Camera: Topcon TRC-NW8:
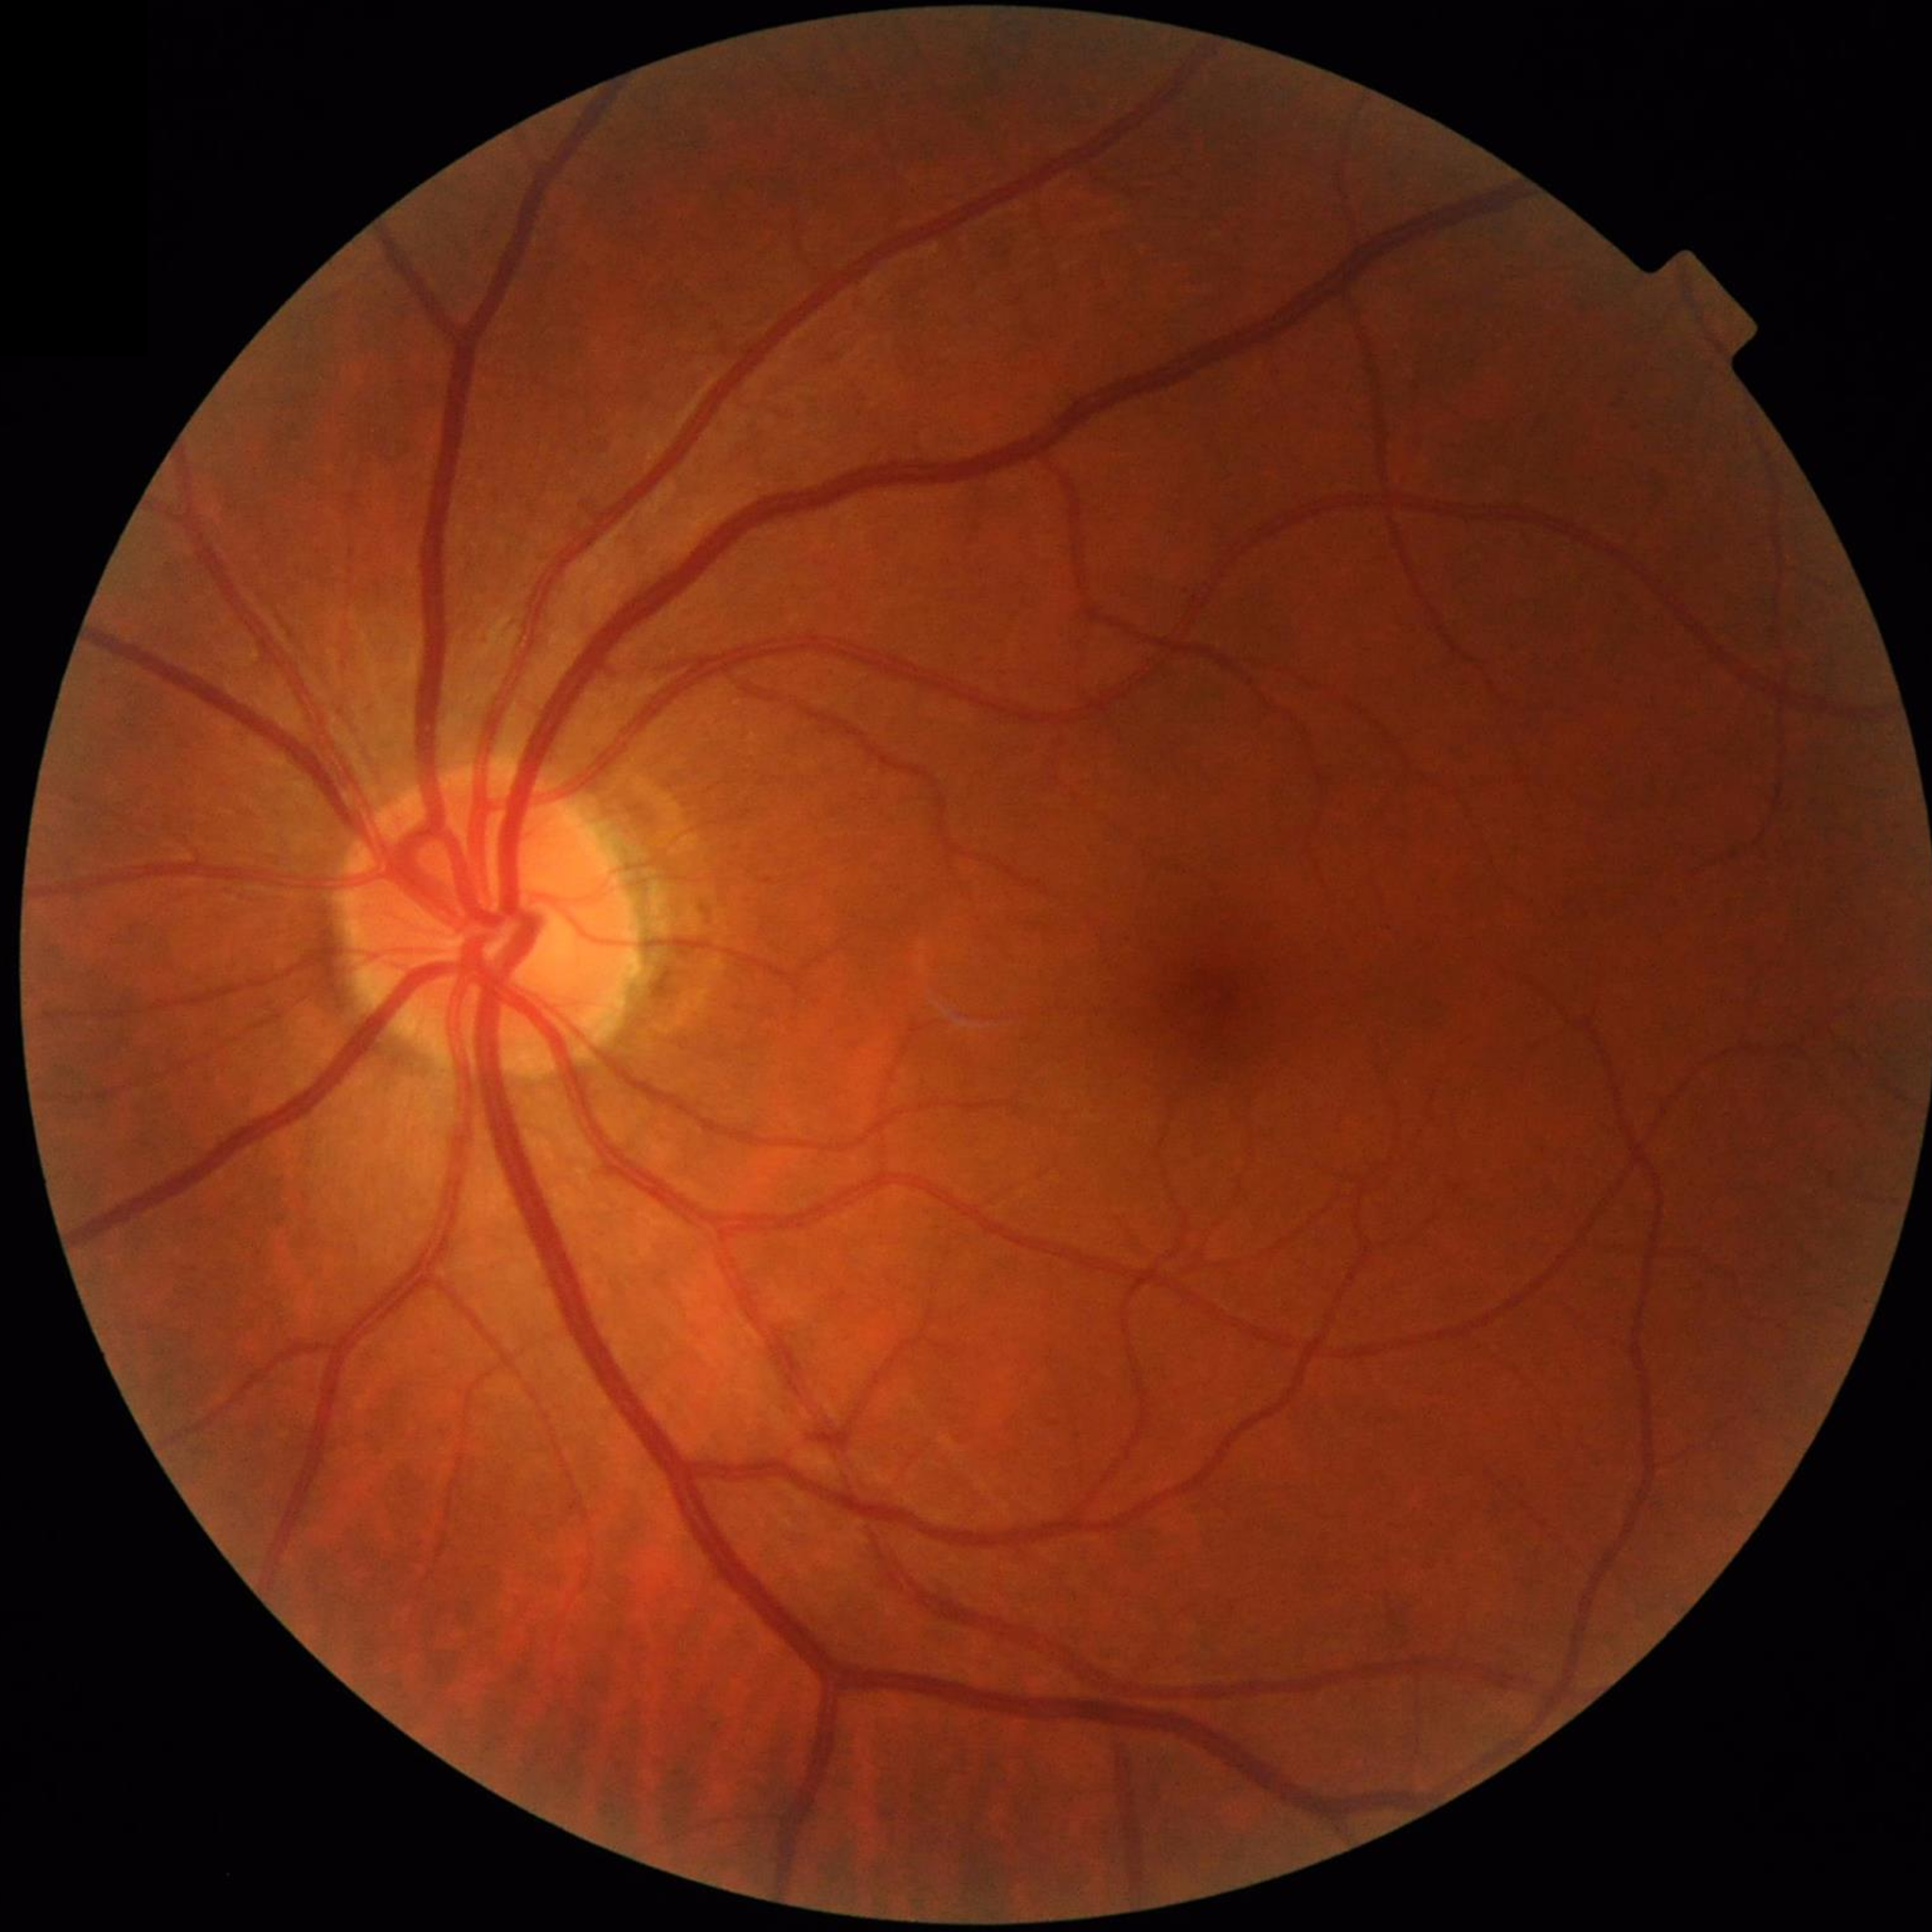
Condition: control (no AMD/DR/glaucoma)